Retinal fundus photograph. No pharmacologic dilation. 848x848px. Modified Davis classification. 45 degree fundus photograph — 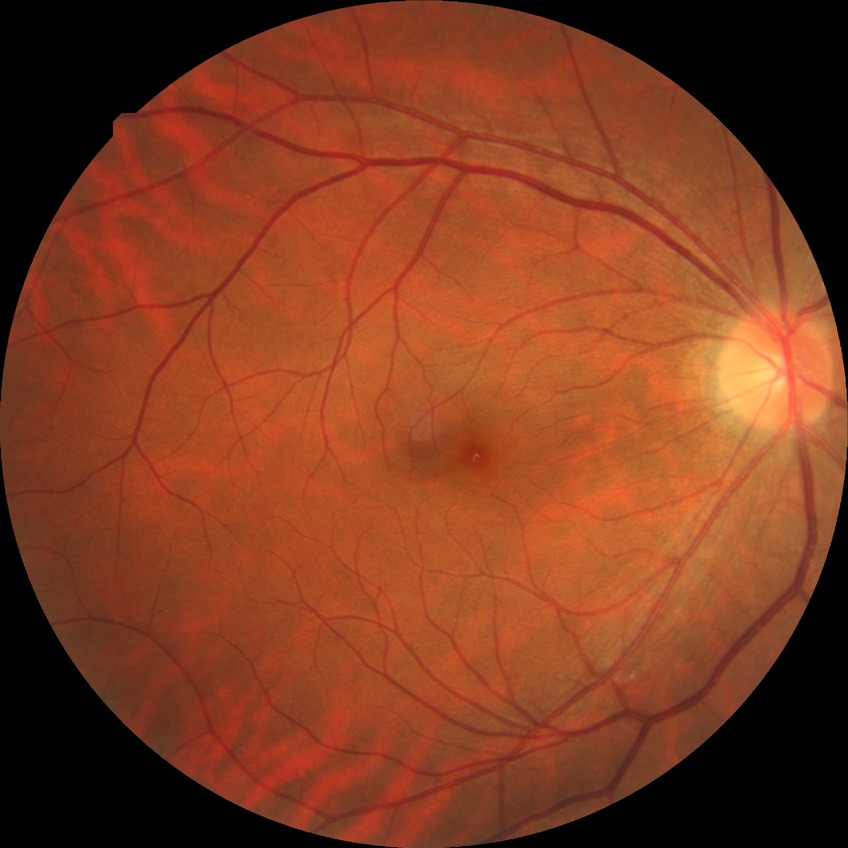
Annotations:
* Davis grade: NDR